240 by 240 pixels. Cropped to the optic nerve head:
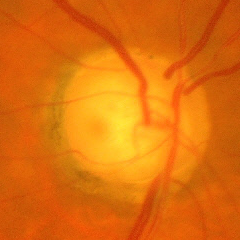 Q: Does this eye have glaucoma?
A: Advanced glaucomatous optic neuropathy.